FOV: 45 degrees. 2352 x 1568 pixels: 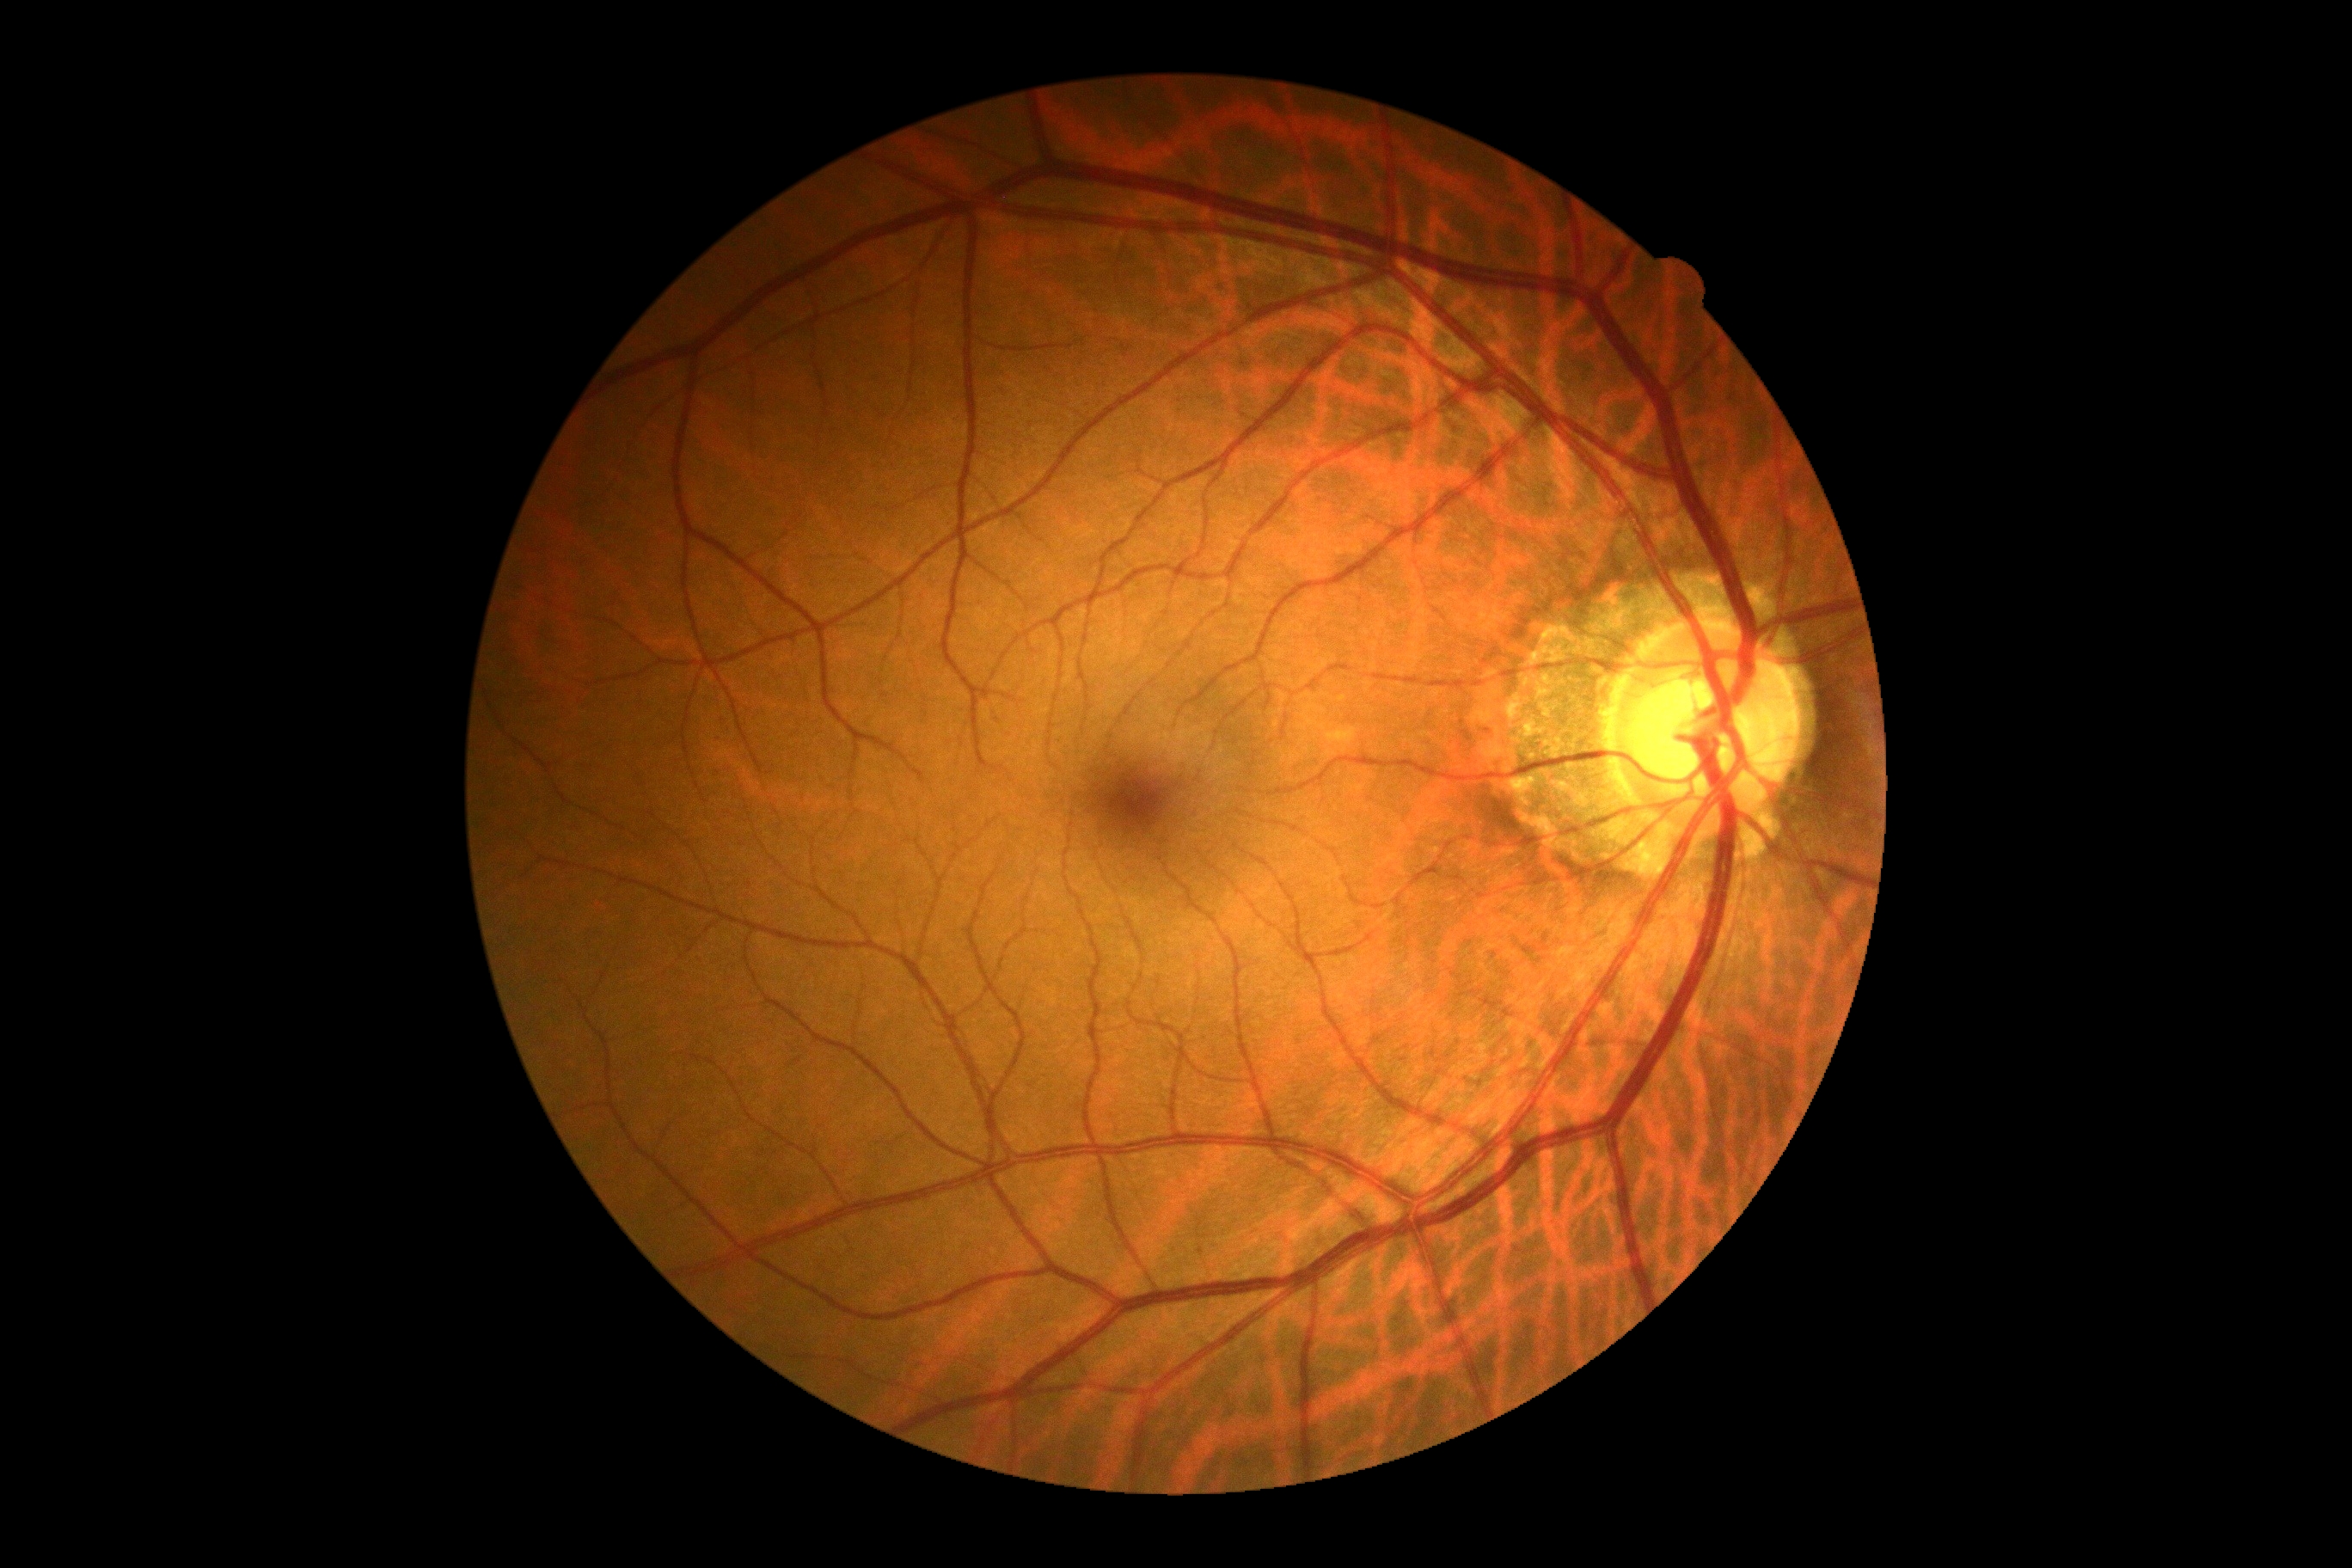

{
  "dr_grade": "no apparent retinopathy (grade 0) — no visible signs of diabetic retinopathy",
  "dr_impression": "no signs of DR"
}